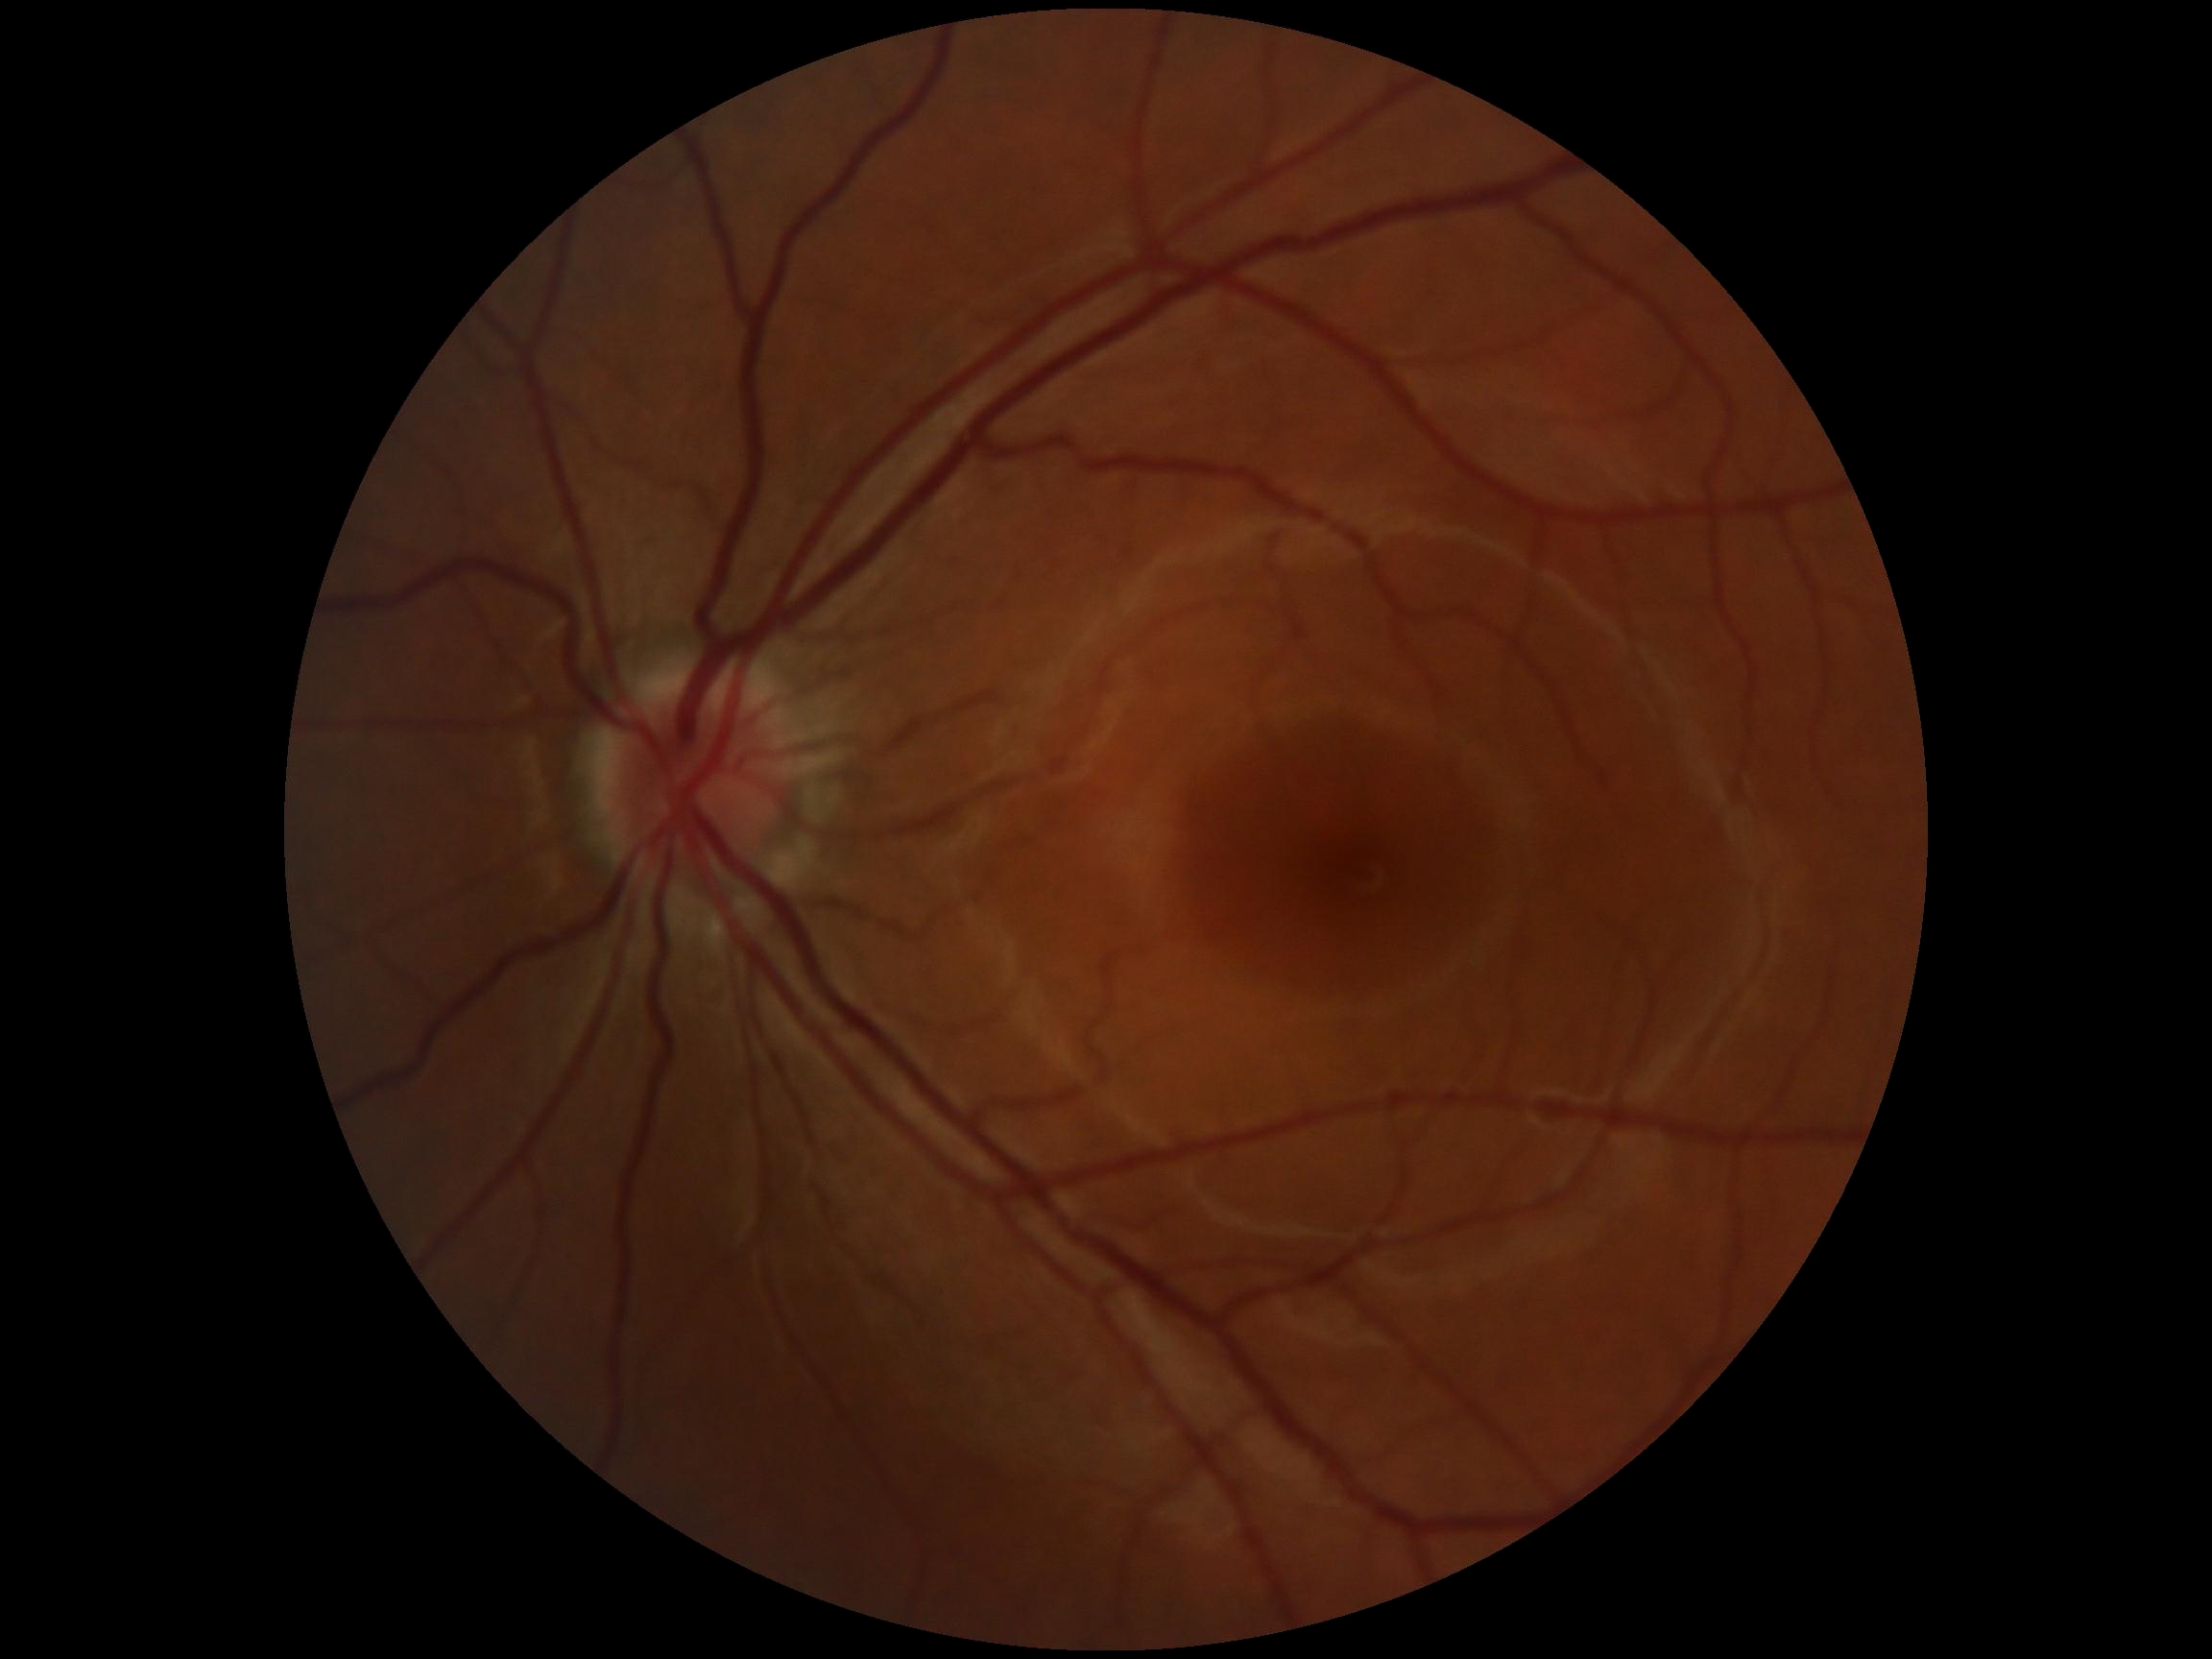

  dr_grade: no apparent retinopathy (0)
  dr_impression: no apparent DR